640 by 480 pixels · wide-field contact fundus photograph of an infant — 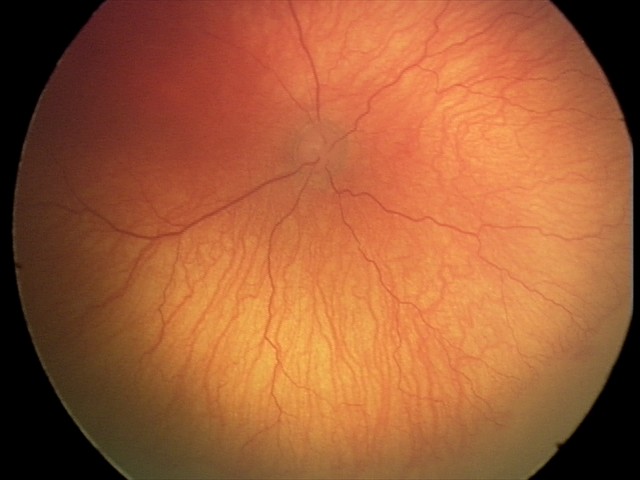

Diagnosis from this screening exam: aggressive ROP (A-ROP).